DR severity per modified Davis staging, NIDEK AFC-230, 45 degree fundus photograph, without pupil dilation — 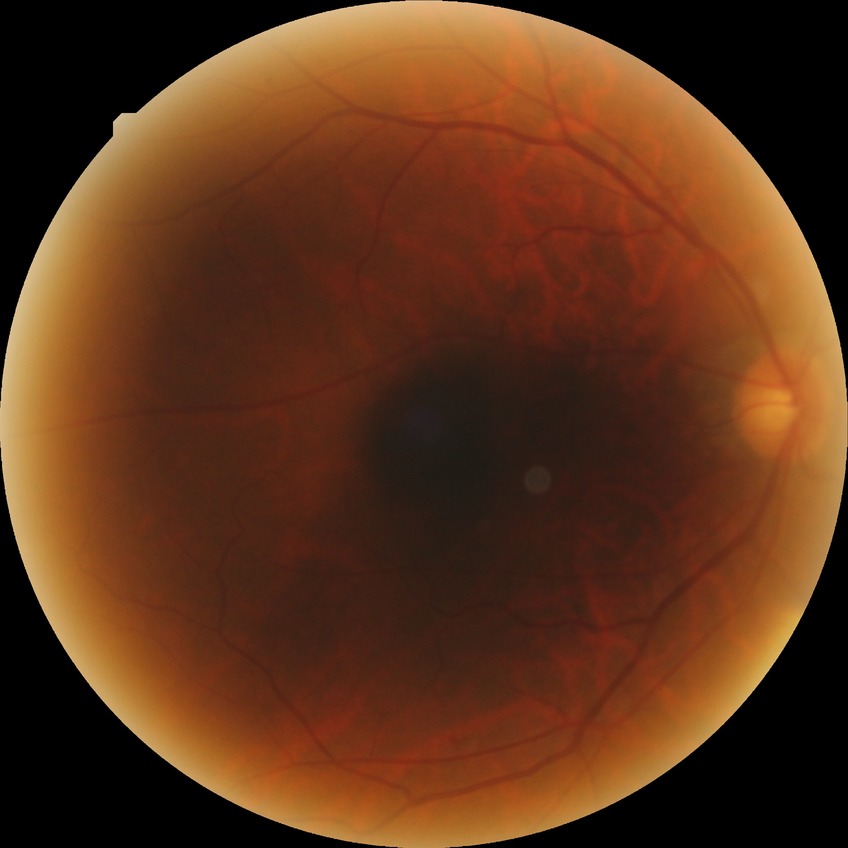
diabetic retinopathy (DR): SDR (simple diabetic retinopathy).